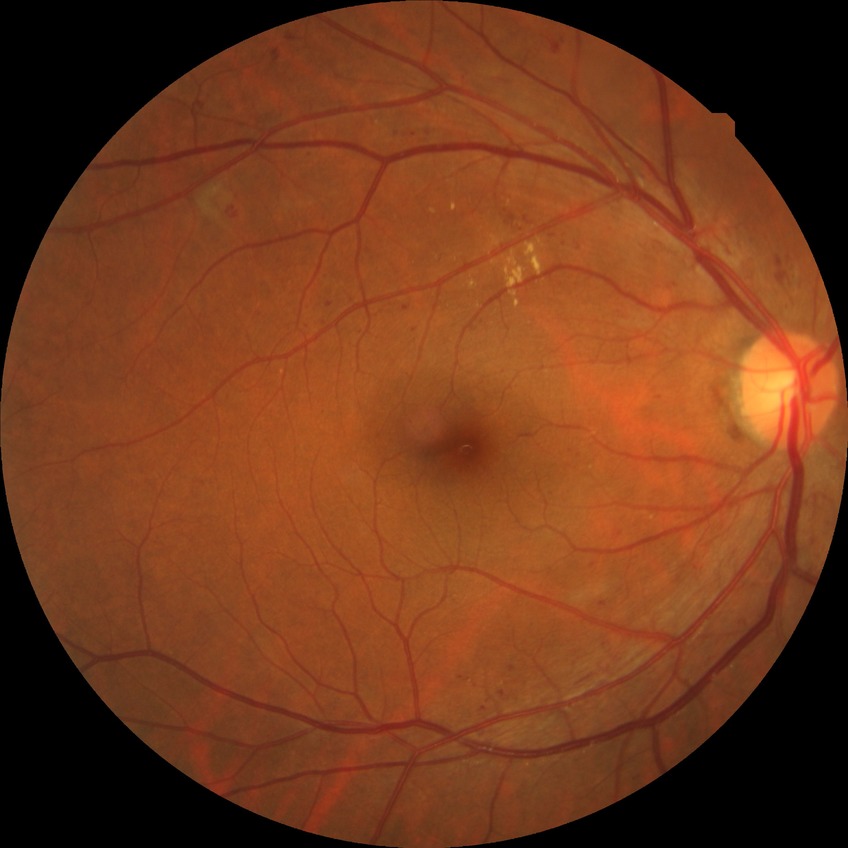 modified Davis classification: simple diabetic retinopathy.